2212 by 1659 pixels · retinal fundus photograph
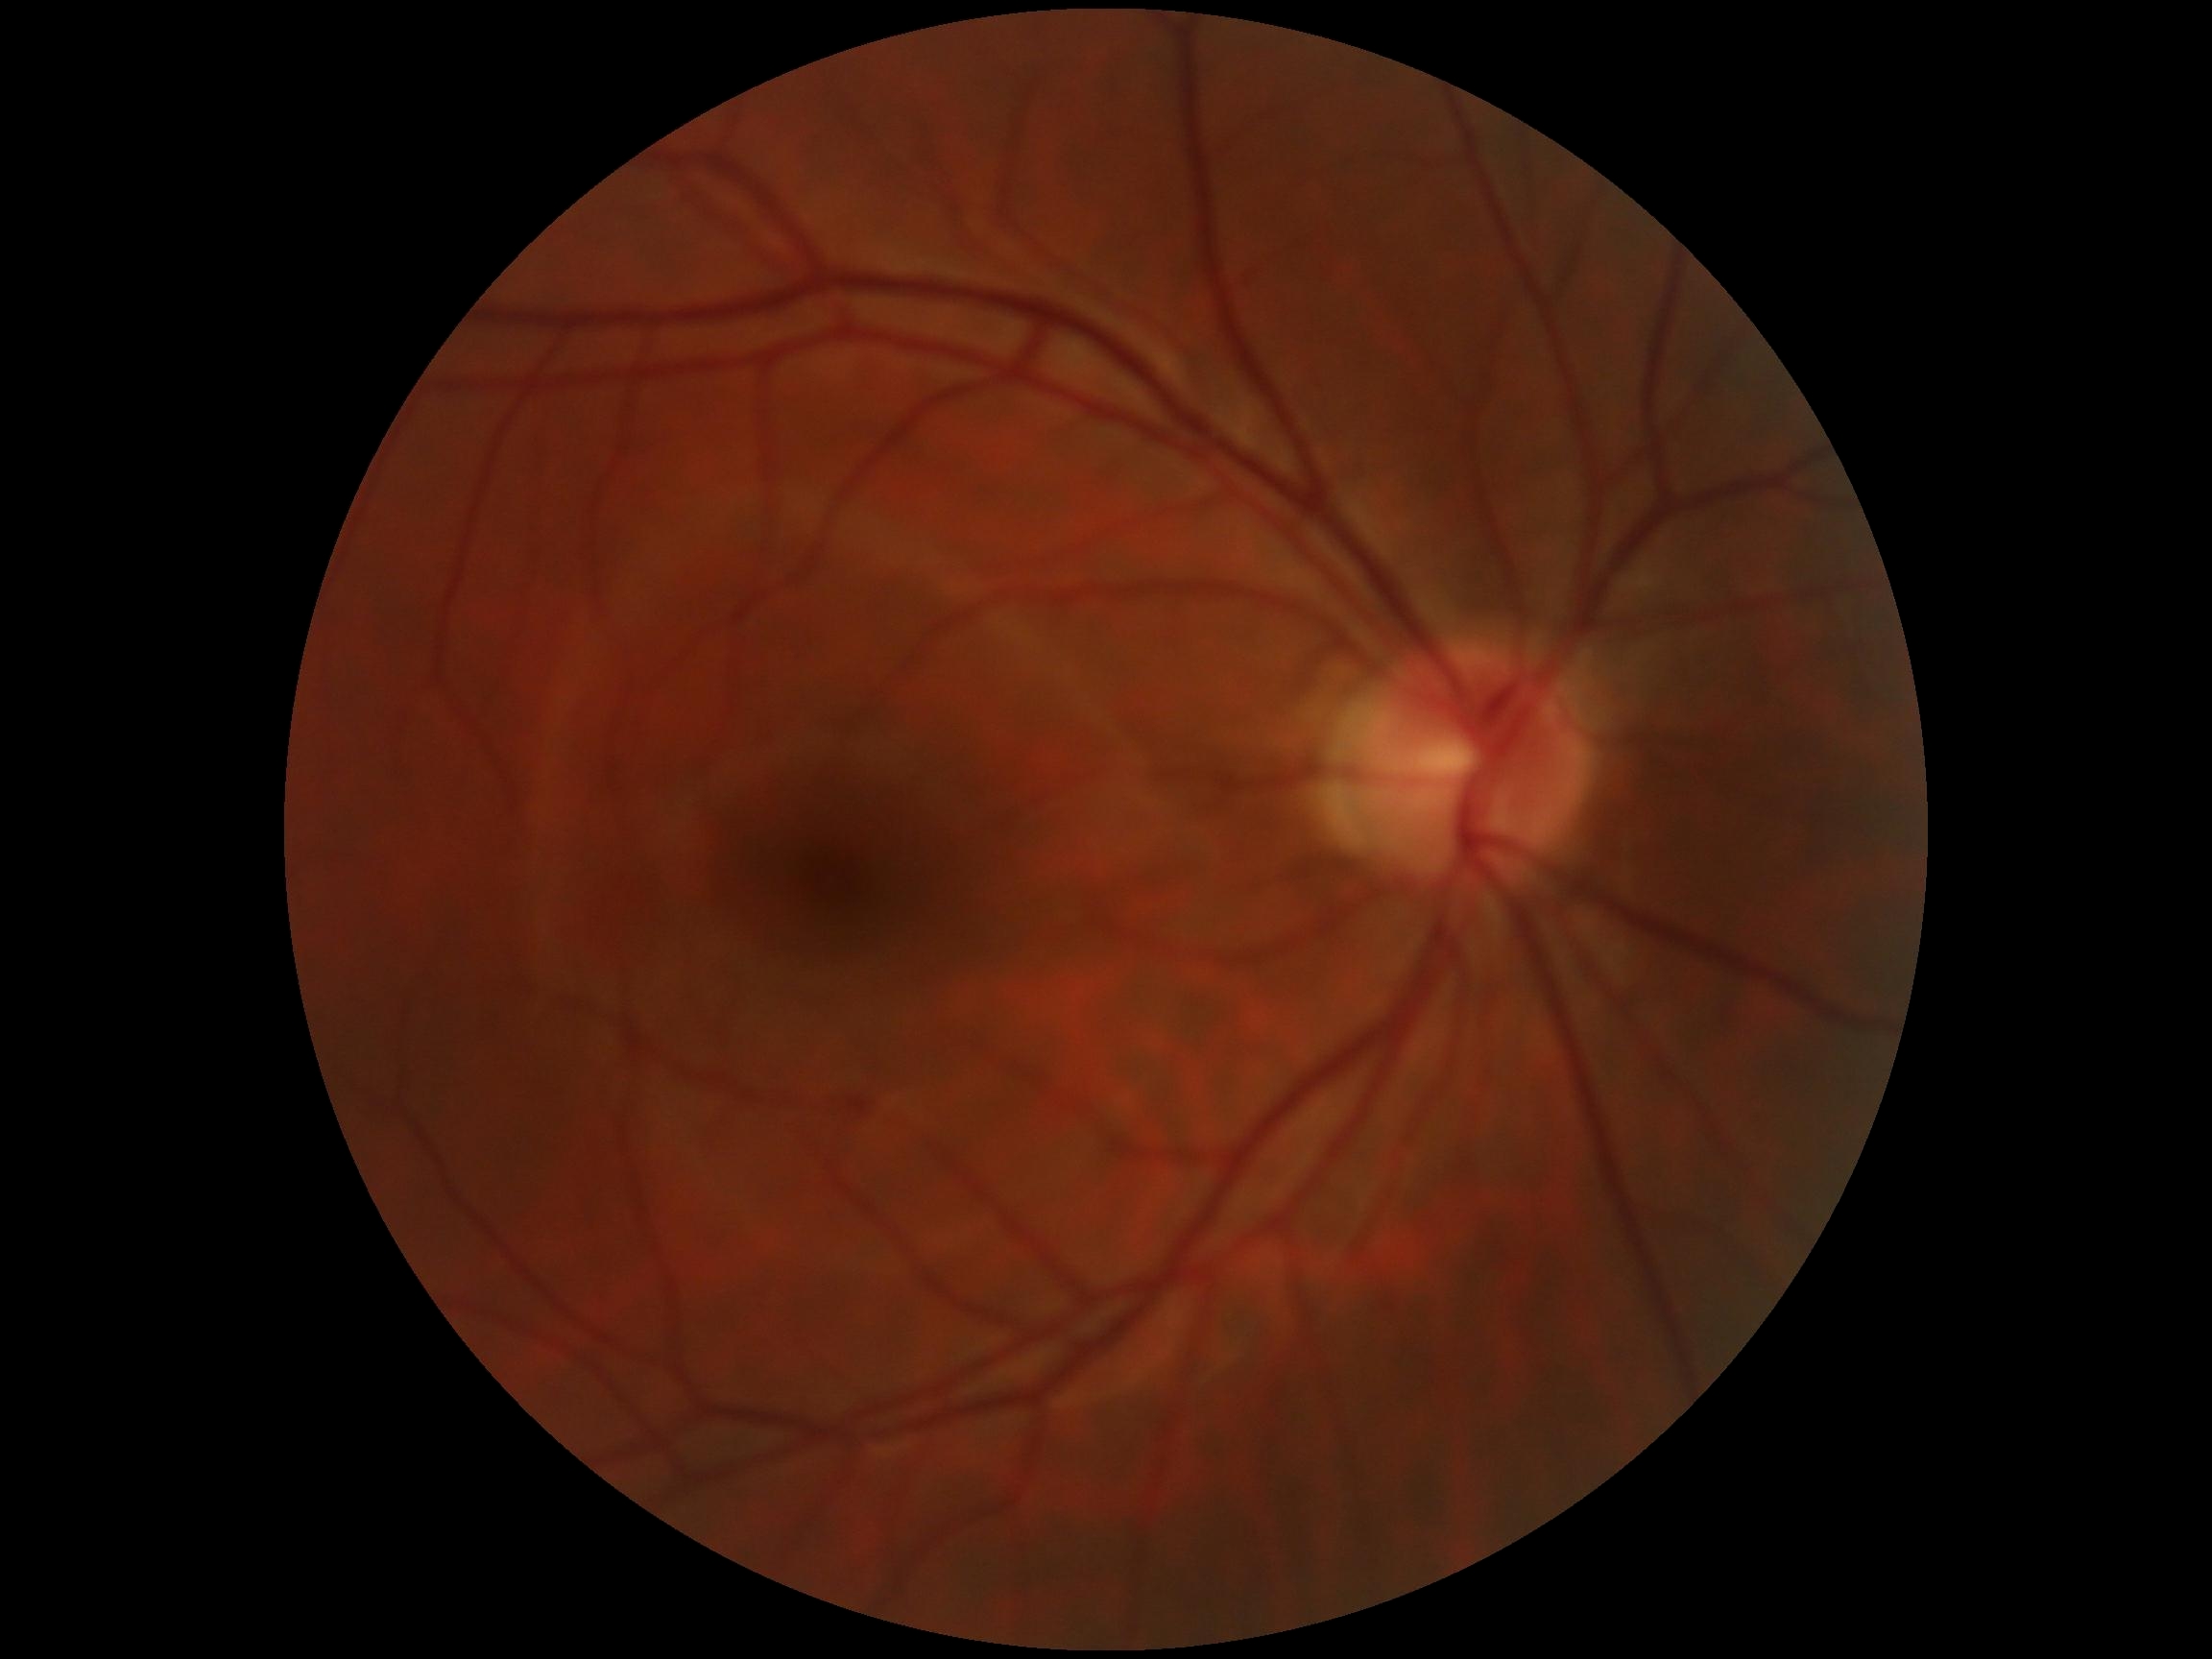 DR grade is no apparent retinopathy (0). No apparent diabetic retinopathy.